2048 by 1536 pixels: 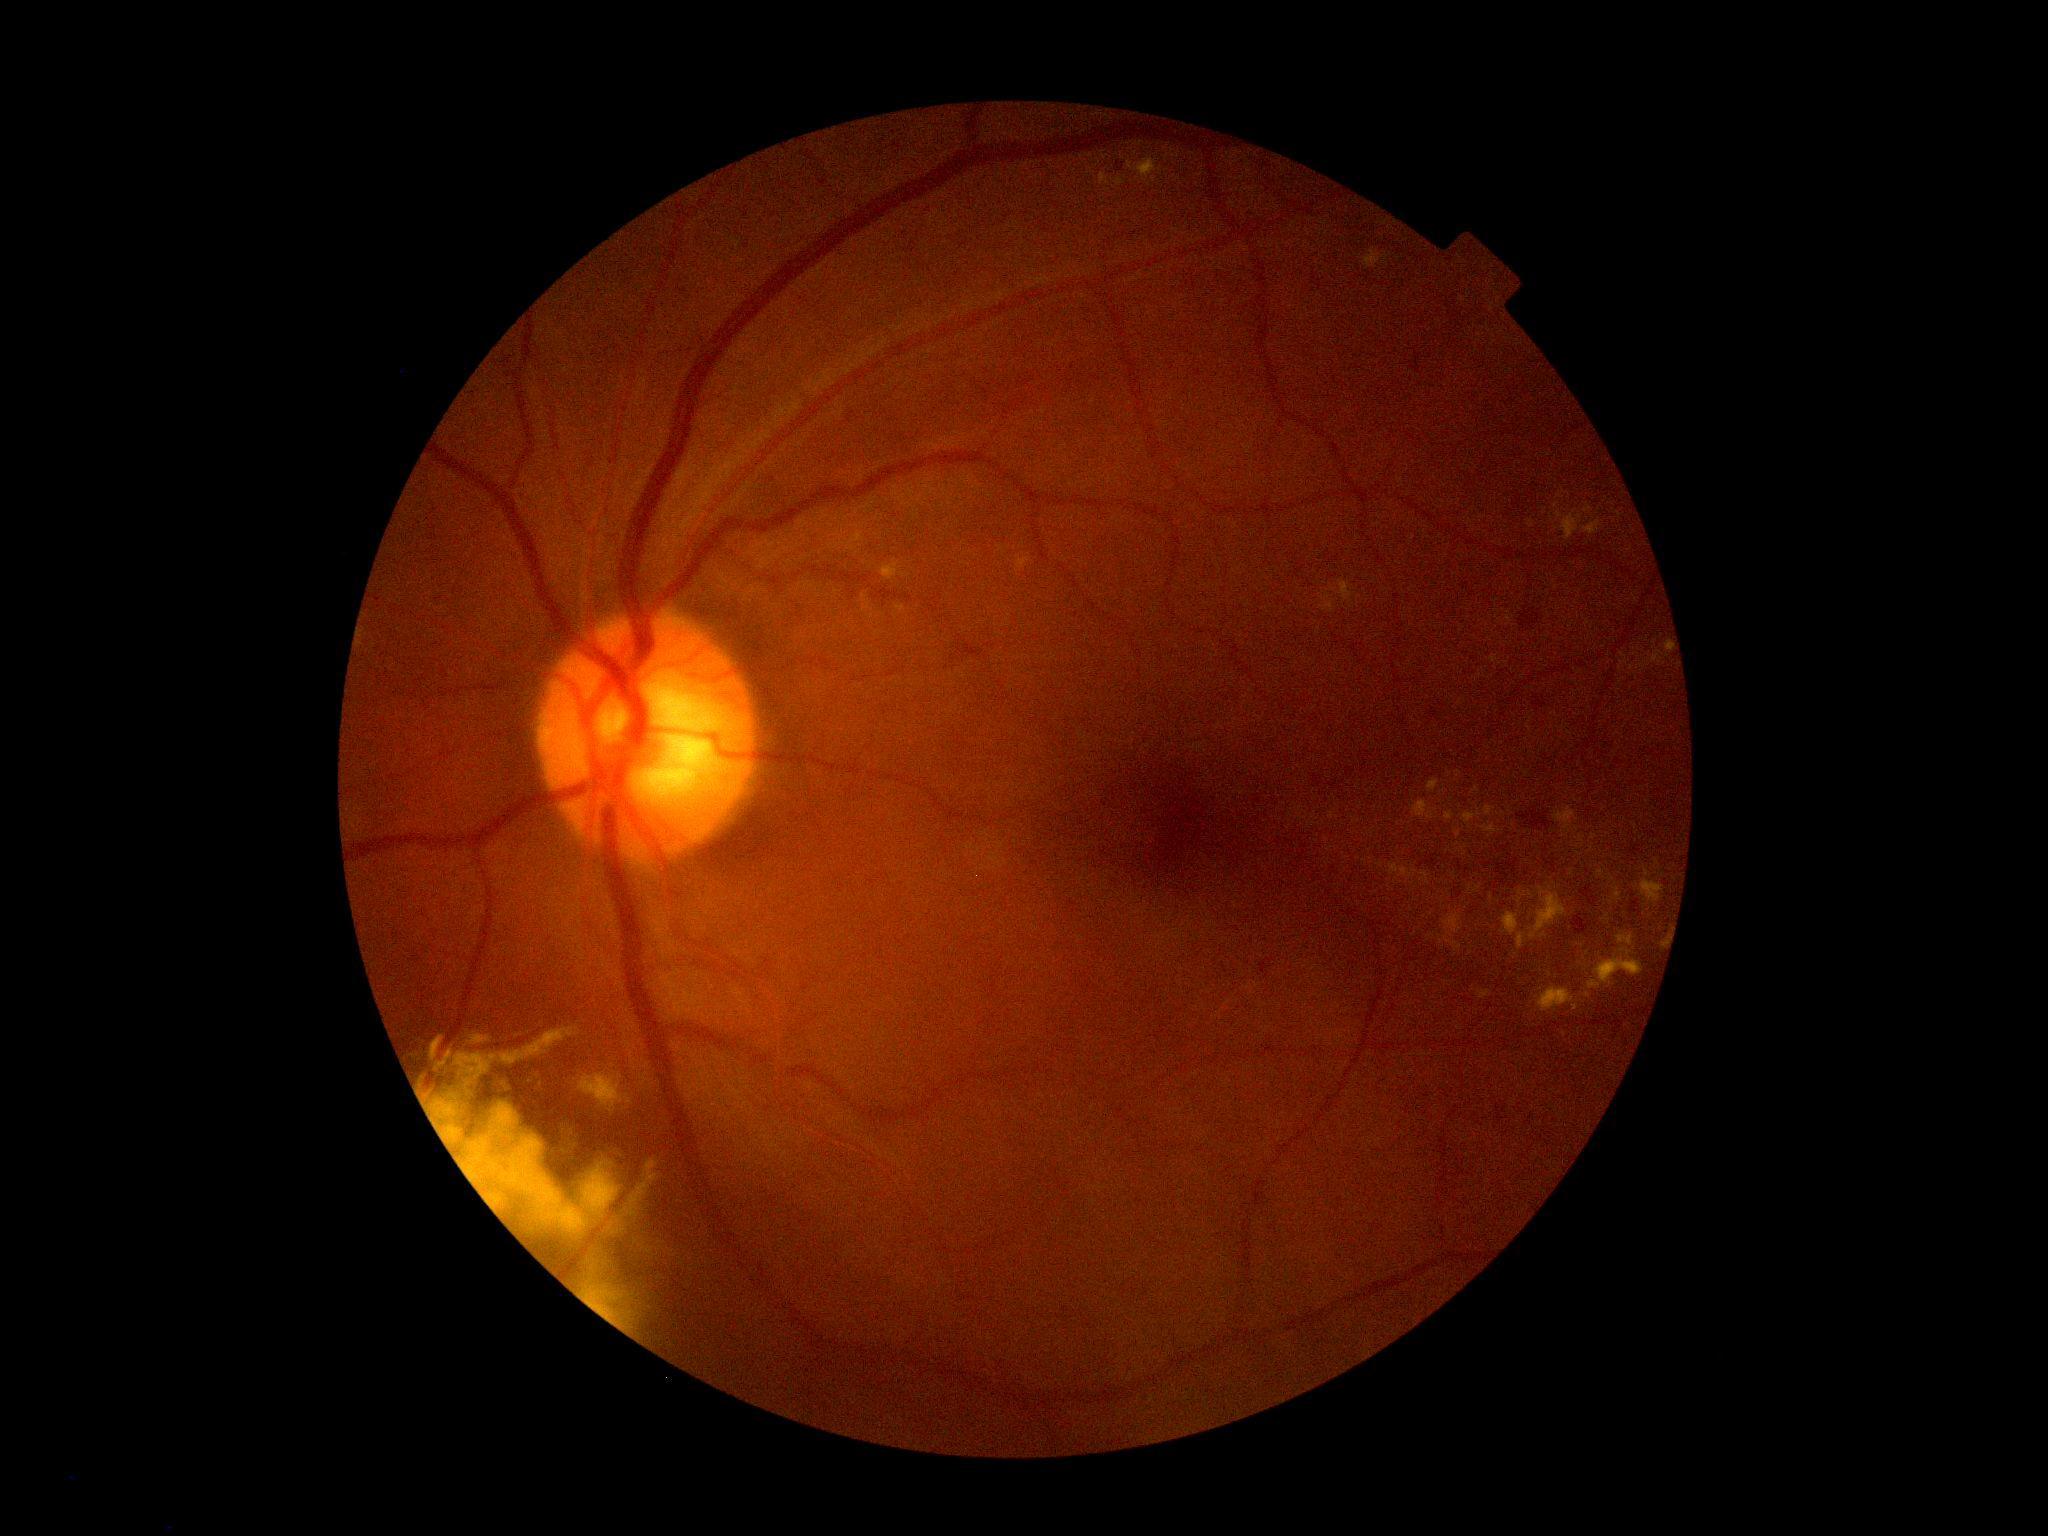
Diabetic retinopathy (DR) is moderate NPDR (grade 2).
No soft exudates (SEs) identified.
No microaneurysms (MAs) identified.
Hard exudates (EXs) are present, including at box(1556, 510, 1583, 541), box(1582, 519, 1603, 535), box(414, 1027, 665, 1339), box(1482, 823, 1501, 838), box(1468, 884, 1482, 895), box(643, 1248, 651, 1254), box(1320, 578, 1355, 613), box(1517, 933, 1527, 950), box(1363, 249, 1392, 269), box(1597, 869, 1605, 879).
EXs (small, approximate centers) near {"x": 1470, "y": 954}, {"x": 1434, "y": 1010}, {"x": 1572, "y": 873}, {"x": 1588, "y": 995}, {"x": 1446, "y": 983}, {"x": 1594, "y": 837}, {"x": 1576, "y": 800}.
Hemorrhages (HEs) are present, including at box(1496, 879, 1507, 889), box(1506, 859, 1519, 875), box(1518, 607, 1540, 630), box(1518, 807, 1552, 831), box(1496, 864, 1509, 880).